Macula-centered field, Topcon TRC-NW8, dilated-pupil acquisition
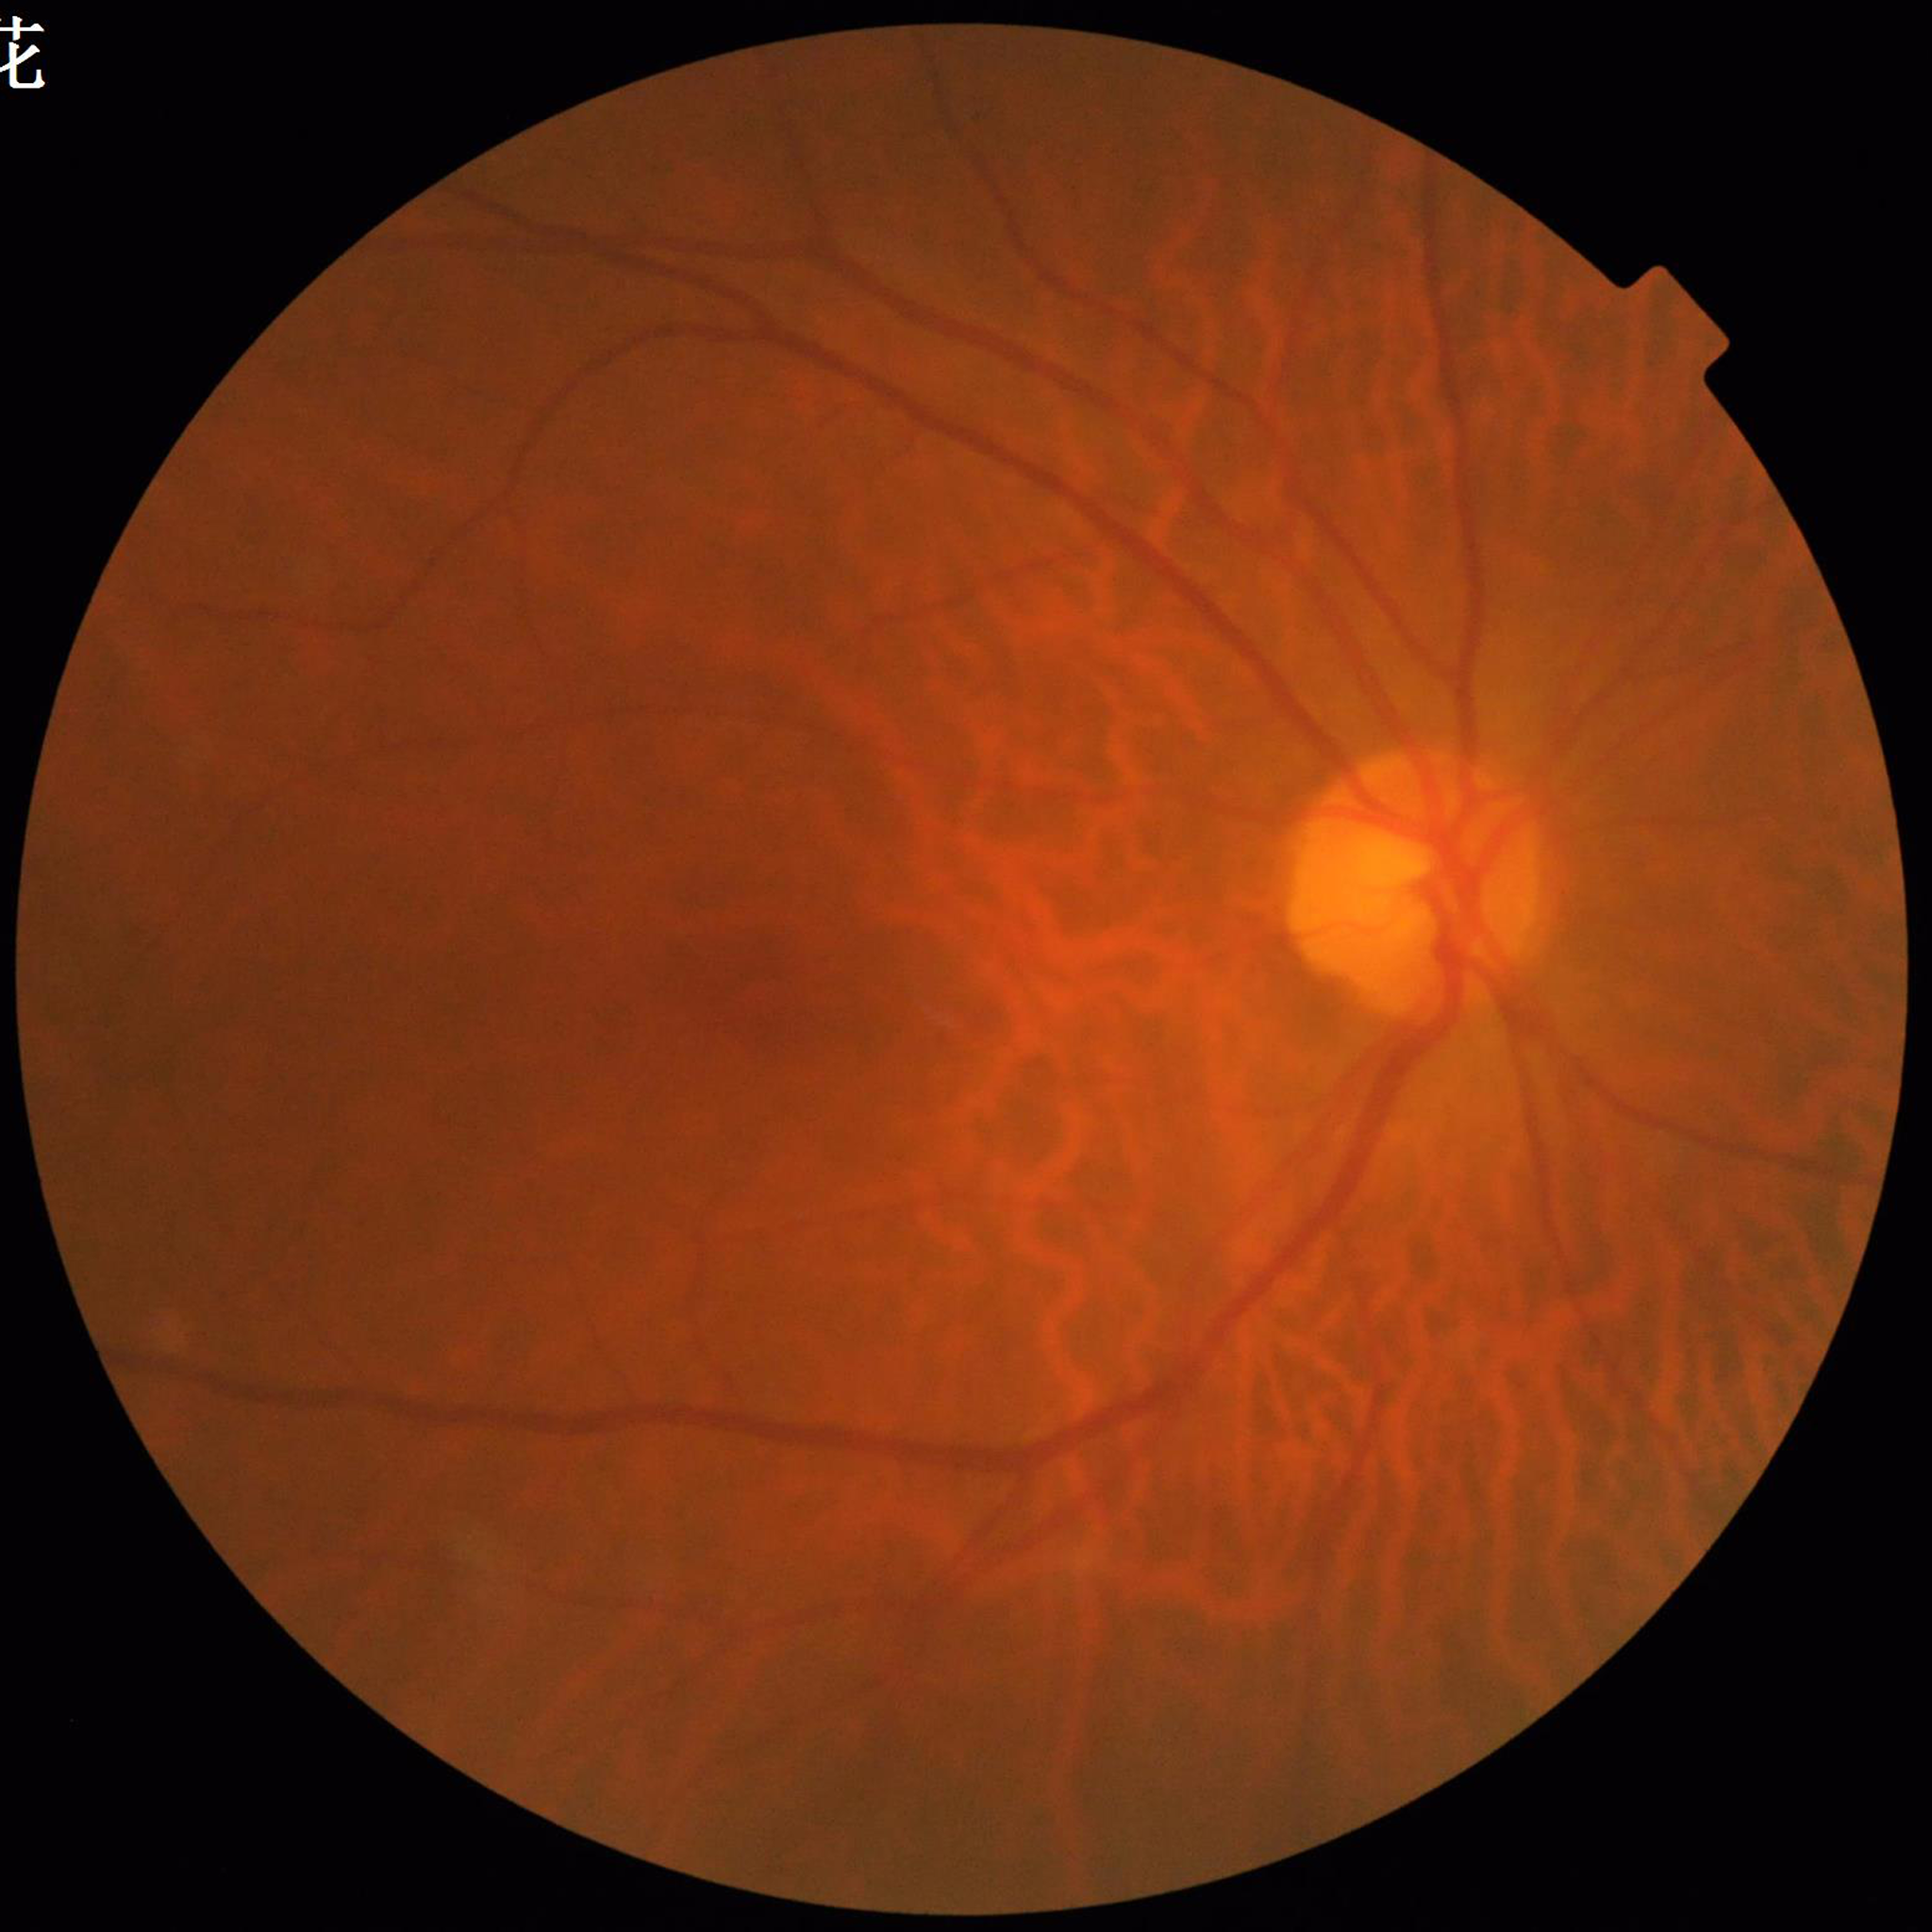
Patient diagnosed with DR.